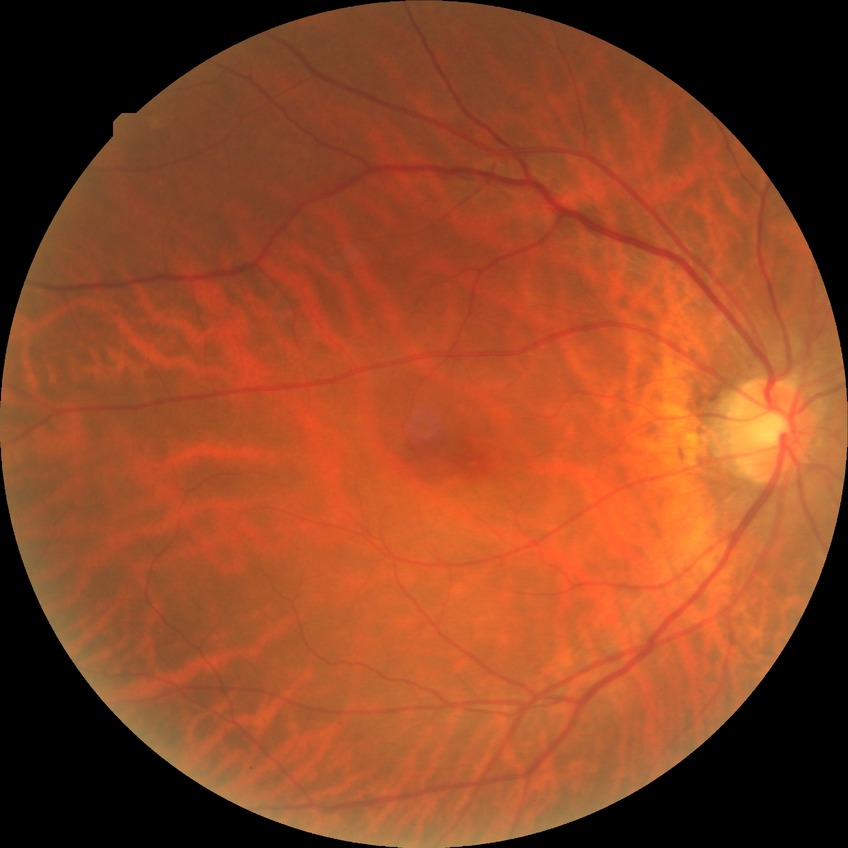

Modified Davis classification is no diabetic retinopathy.